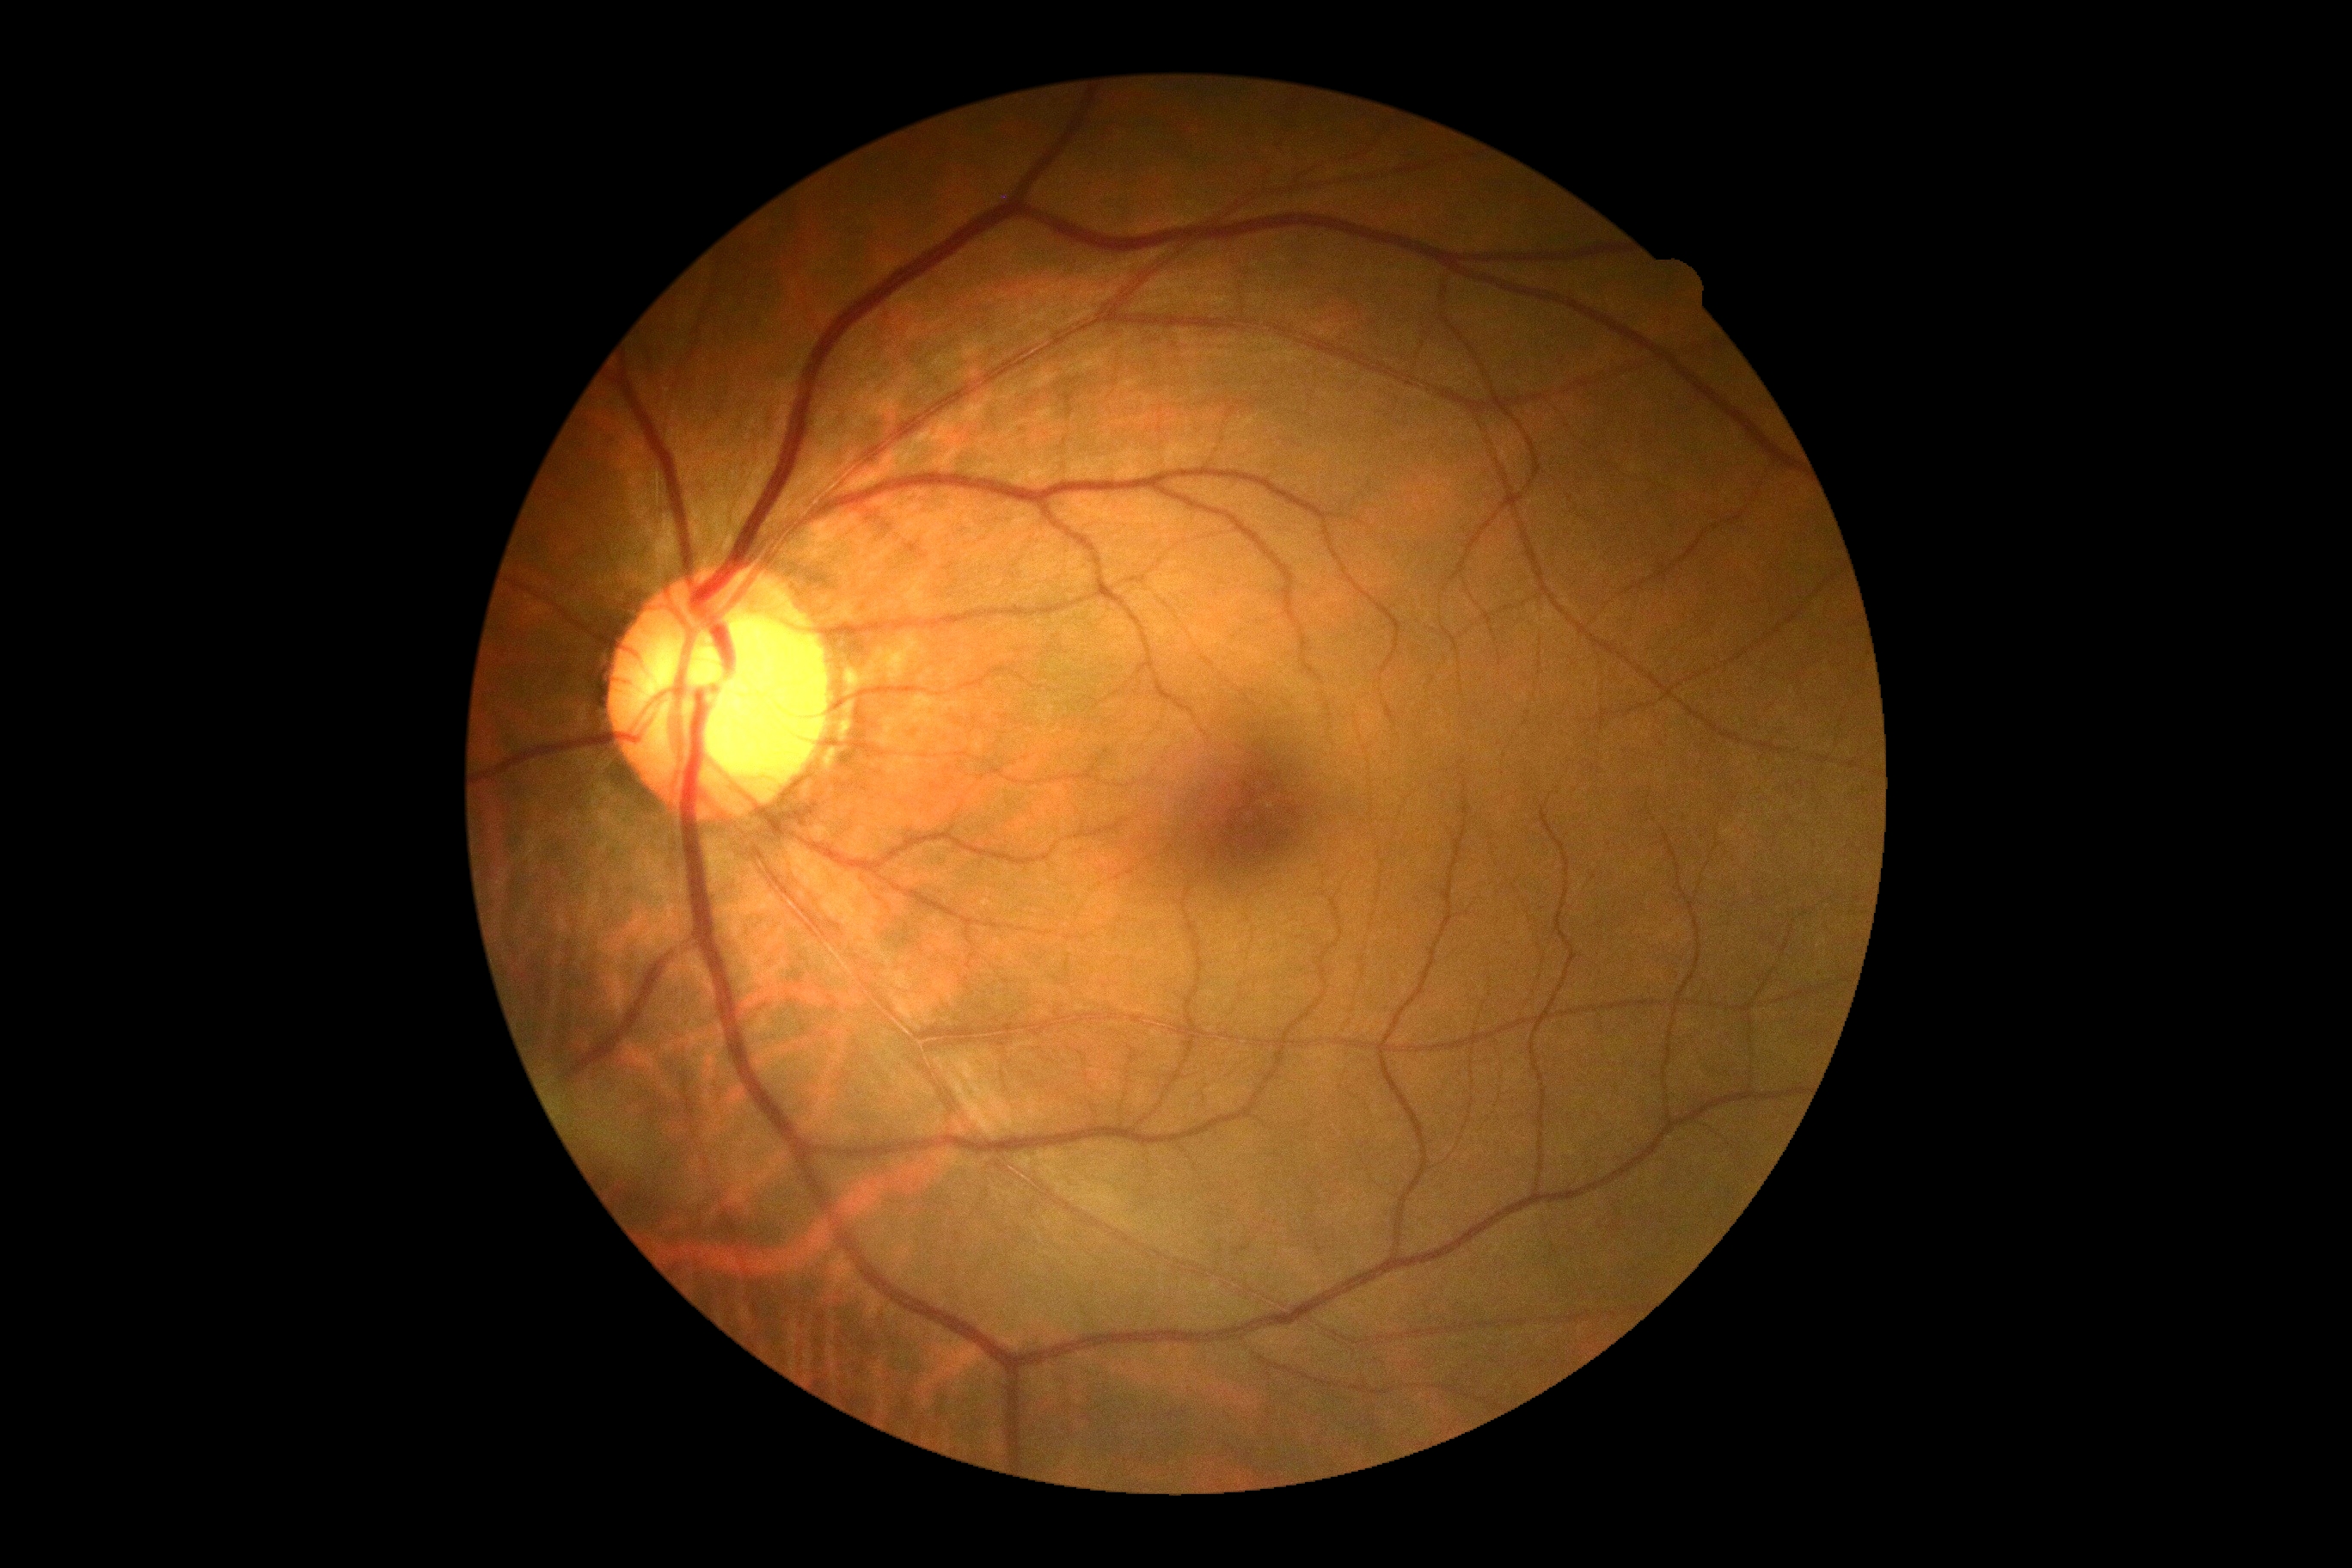 DR: grade 0 (no apparent retinopathy) — no visible signs of diabetic retinopathy.